Phoenix ICON, 100° FOV; 1240 x 1240 pixels; wide-field fundus photograph of an infant — 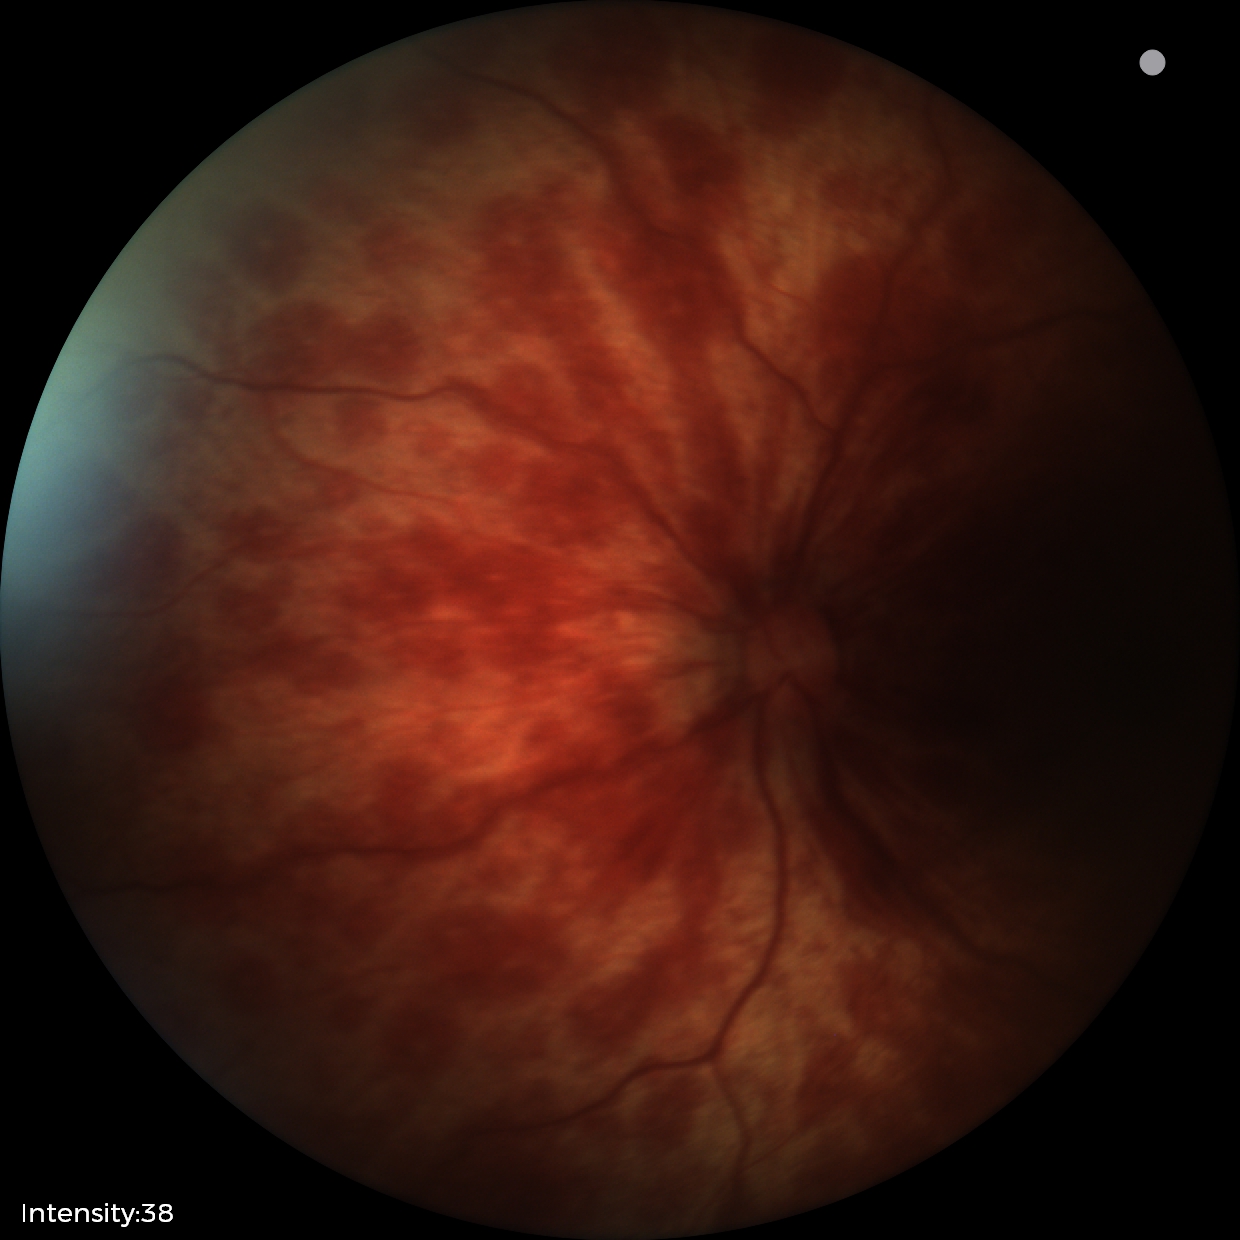

Screening: retinal hemorrhages.